848 by 848 pixels, color fundus image, NIDEK AFC-230 fundus camera, without pupil dilation, diabetic retinopathy graded by the modified Davis classification, 45° FOV.
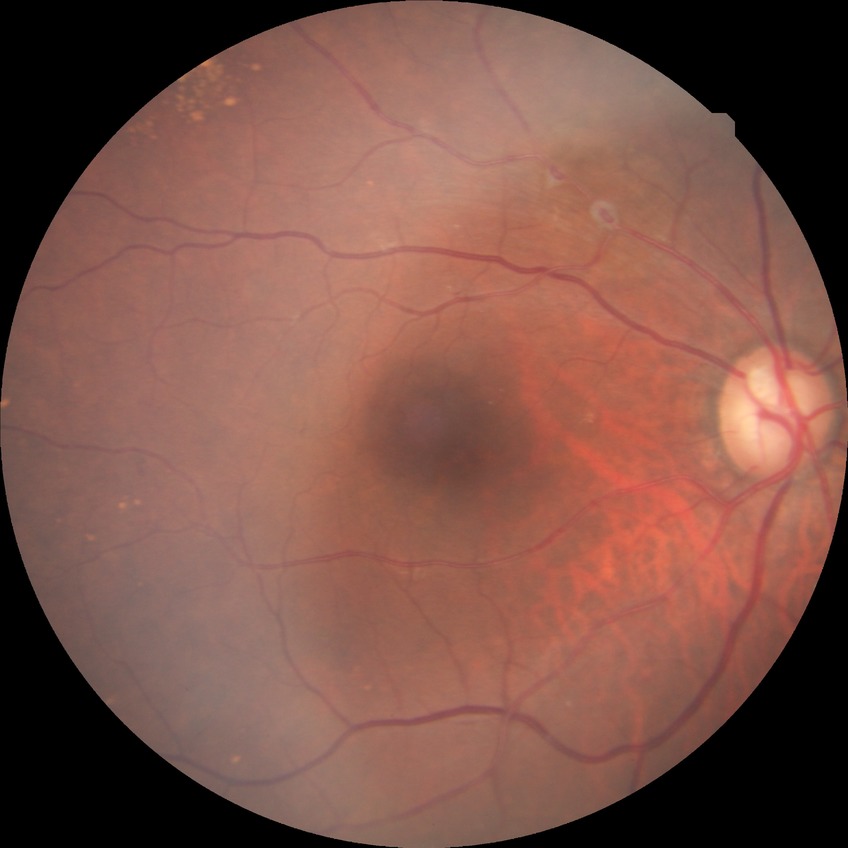 Davis grading is no diabetic retinopathy.